Color fundus photograph; 1932x1932:
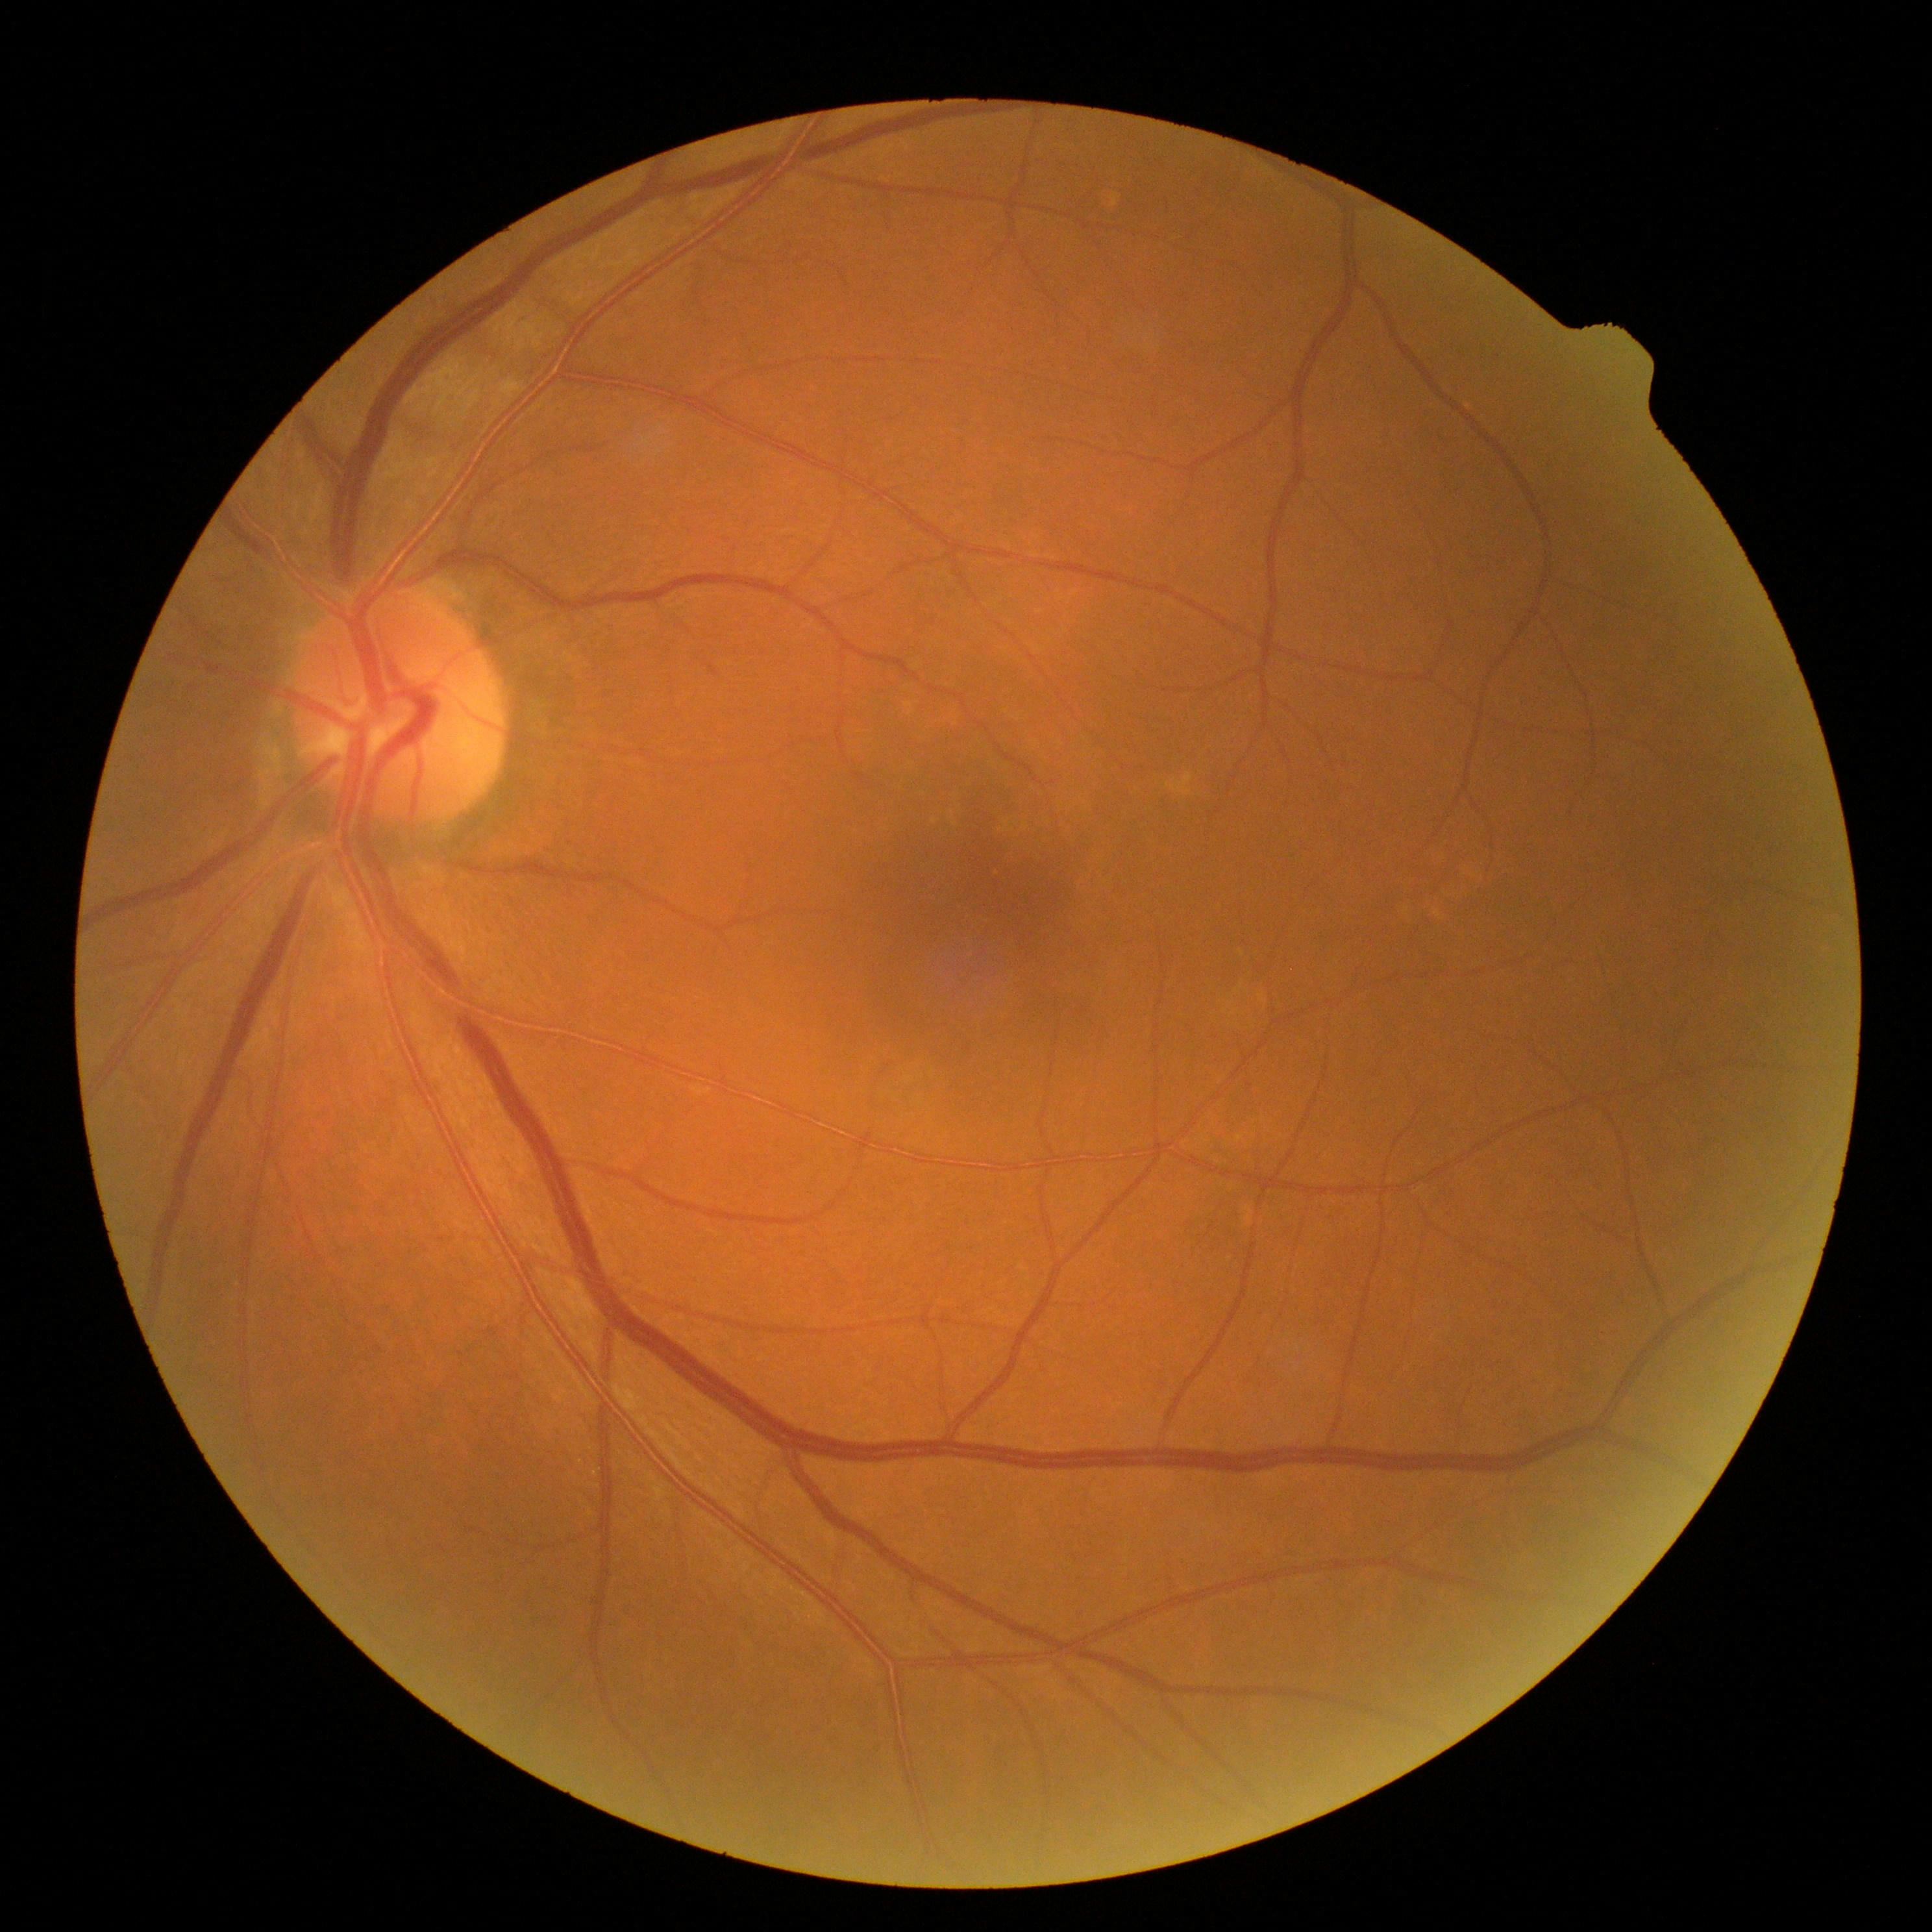 dr_impression: negative for DR
dr_grade: no apparent diabetic retinopathy (grade 0)